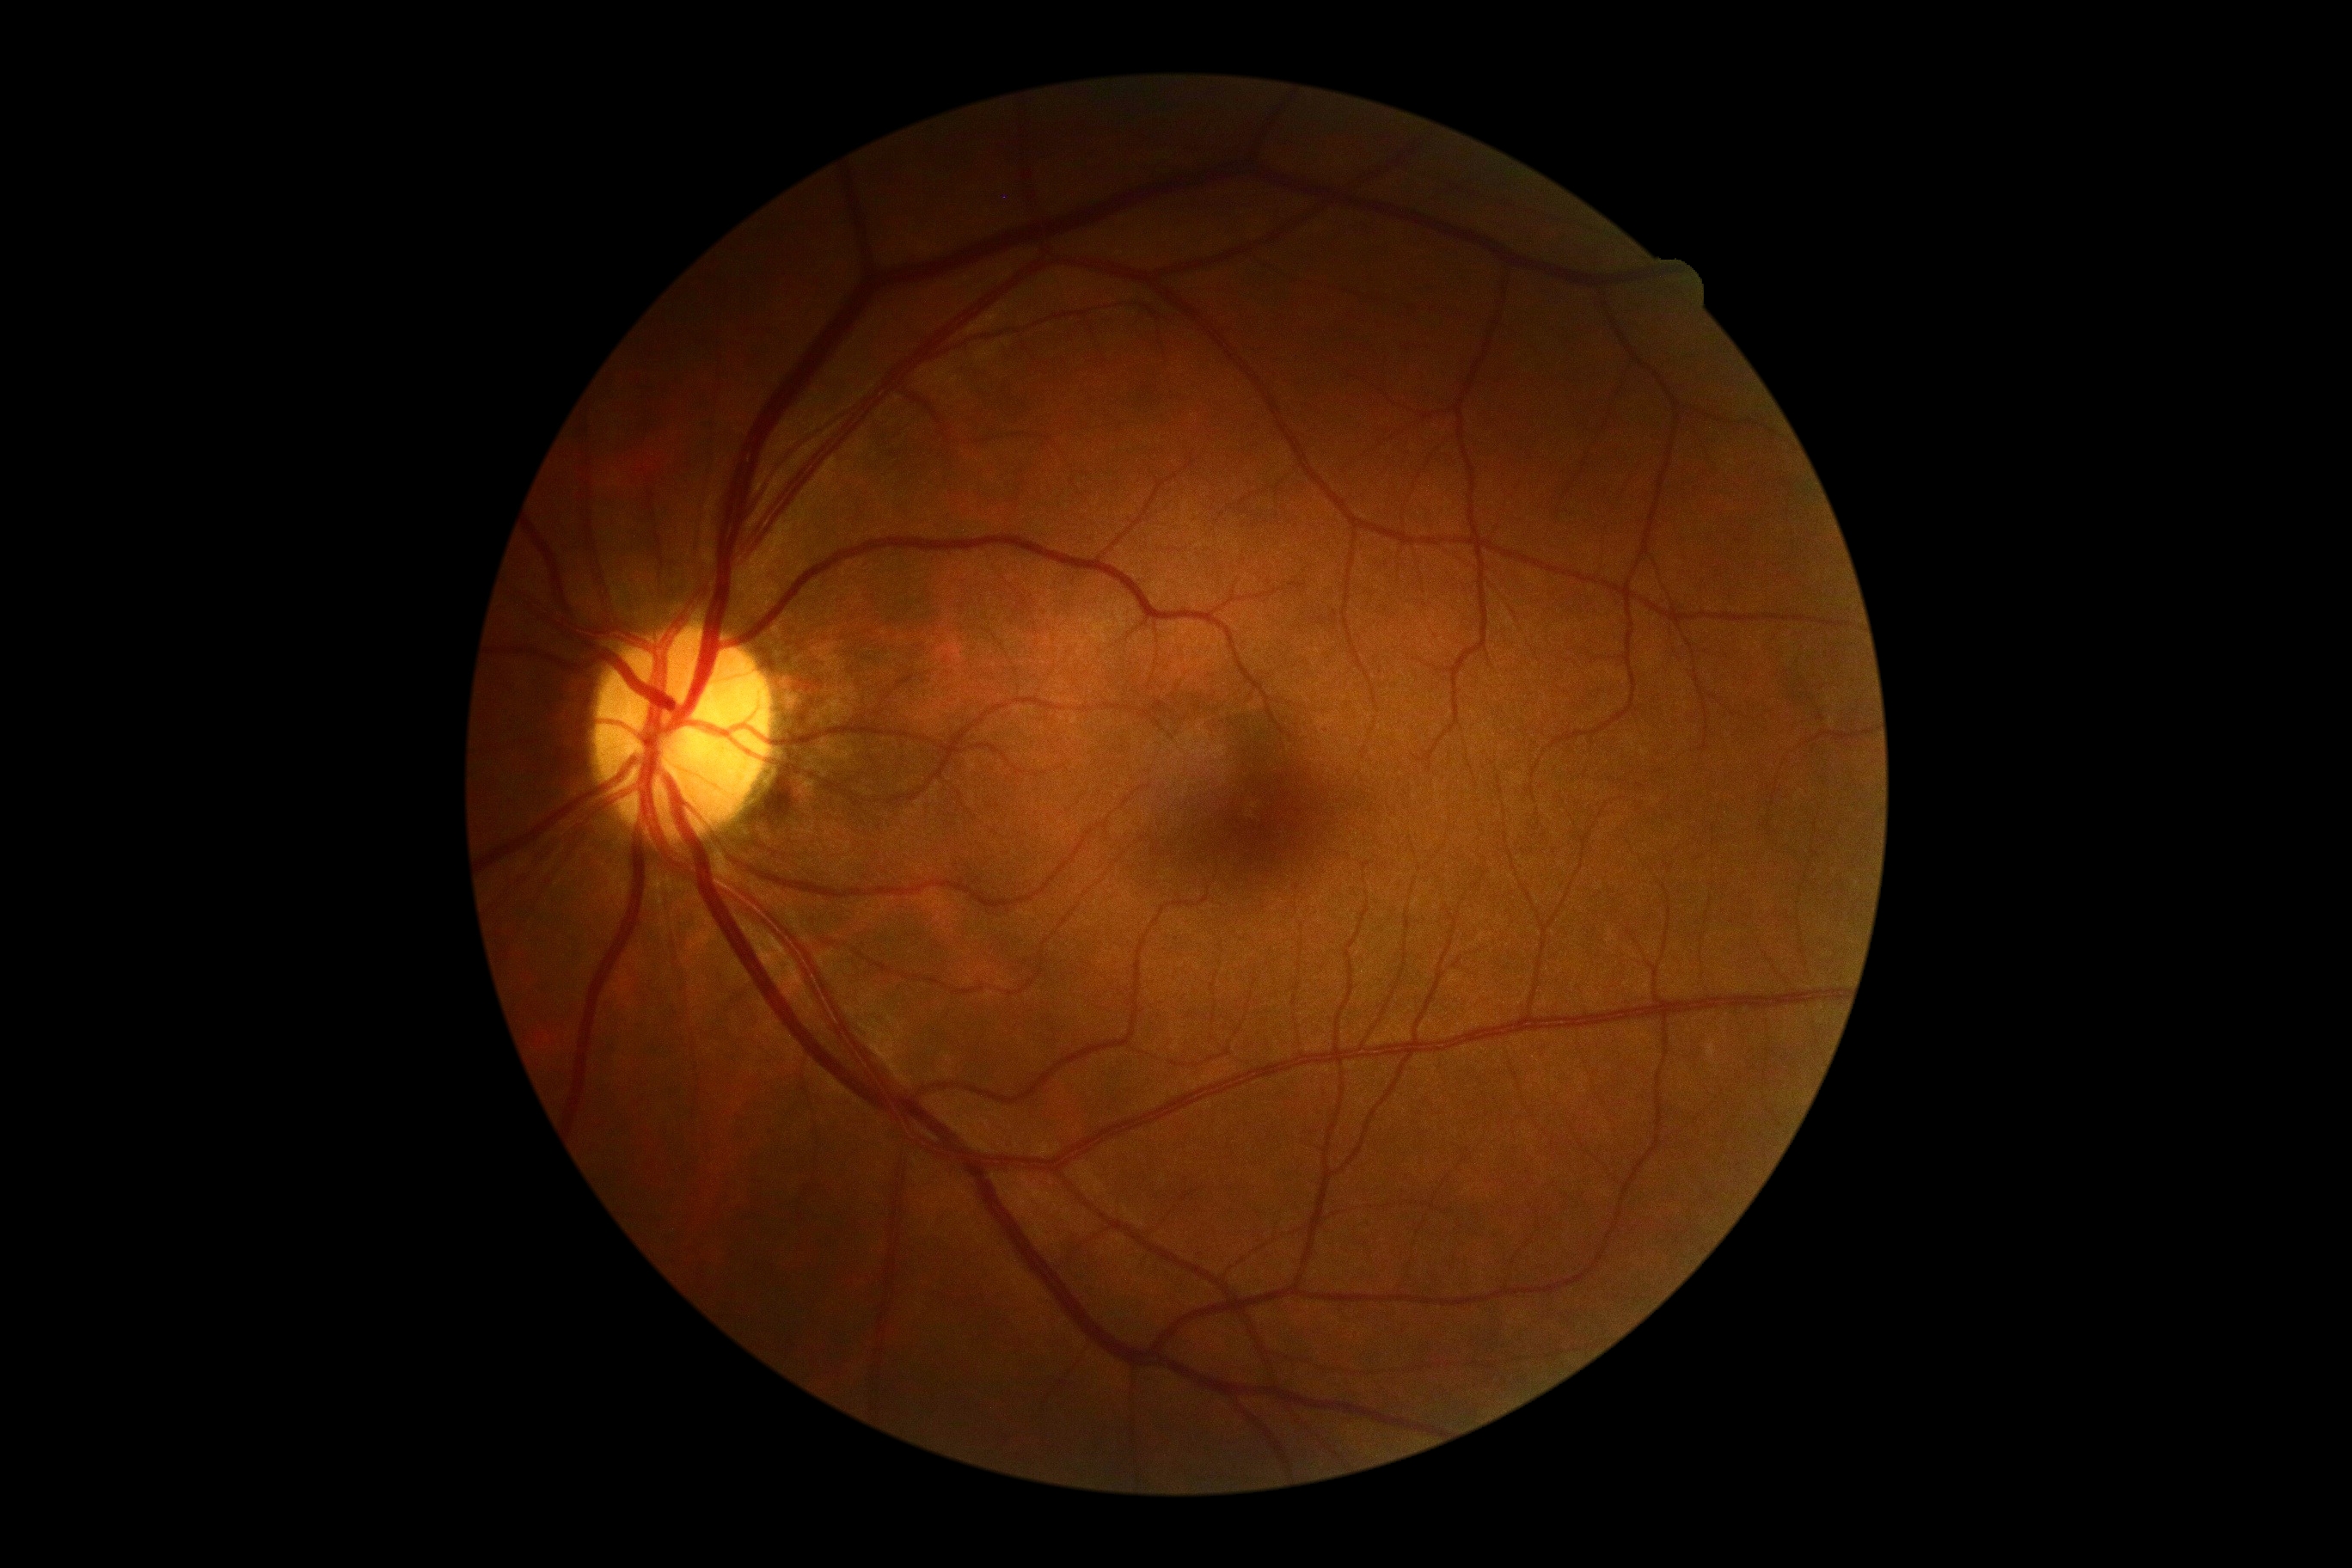
Annotations:
• DR stage: 0/4